45° FOV, color fundus image: 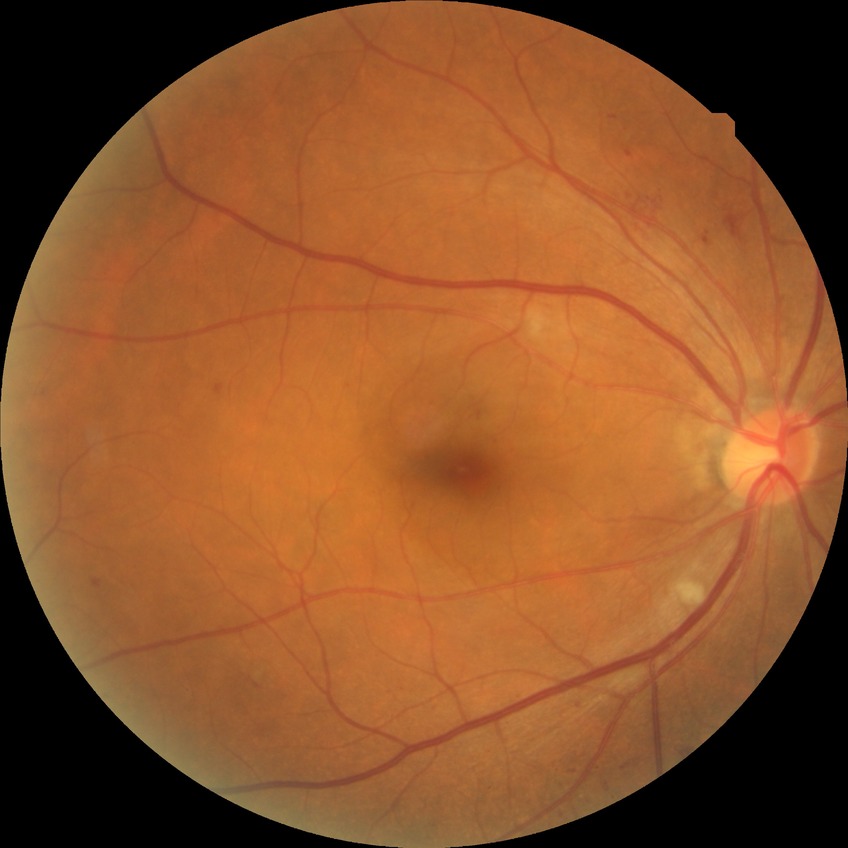
retinopathy grade: simple diabetic retinopathy.